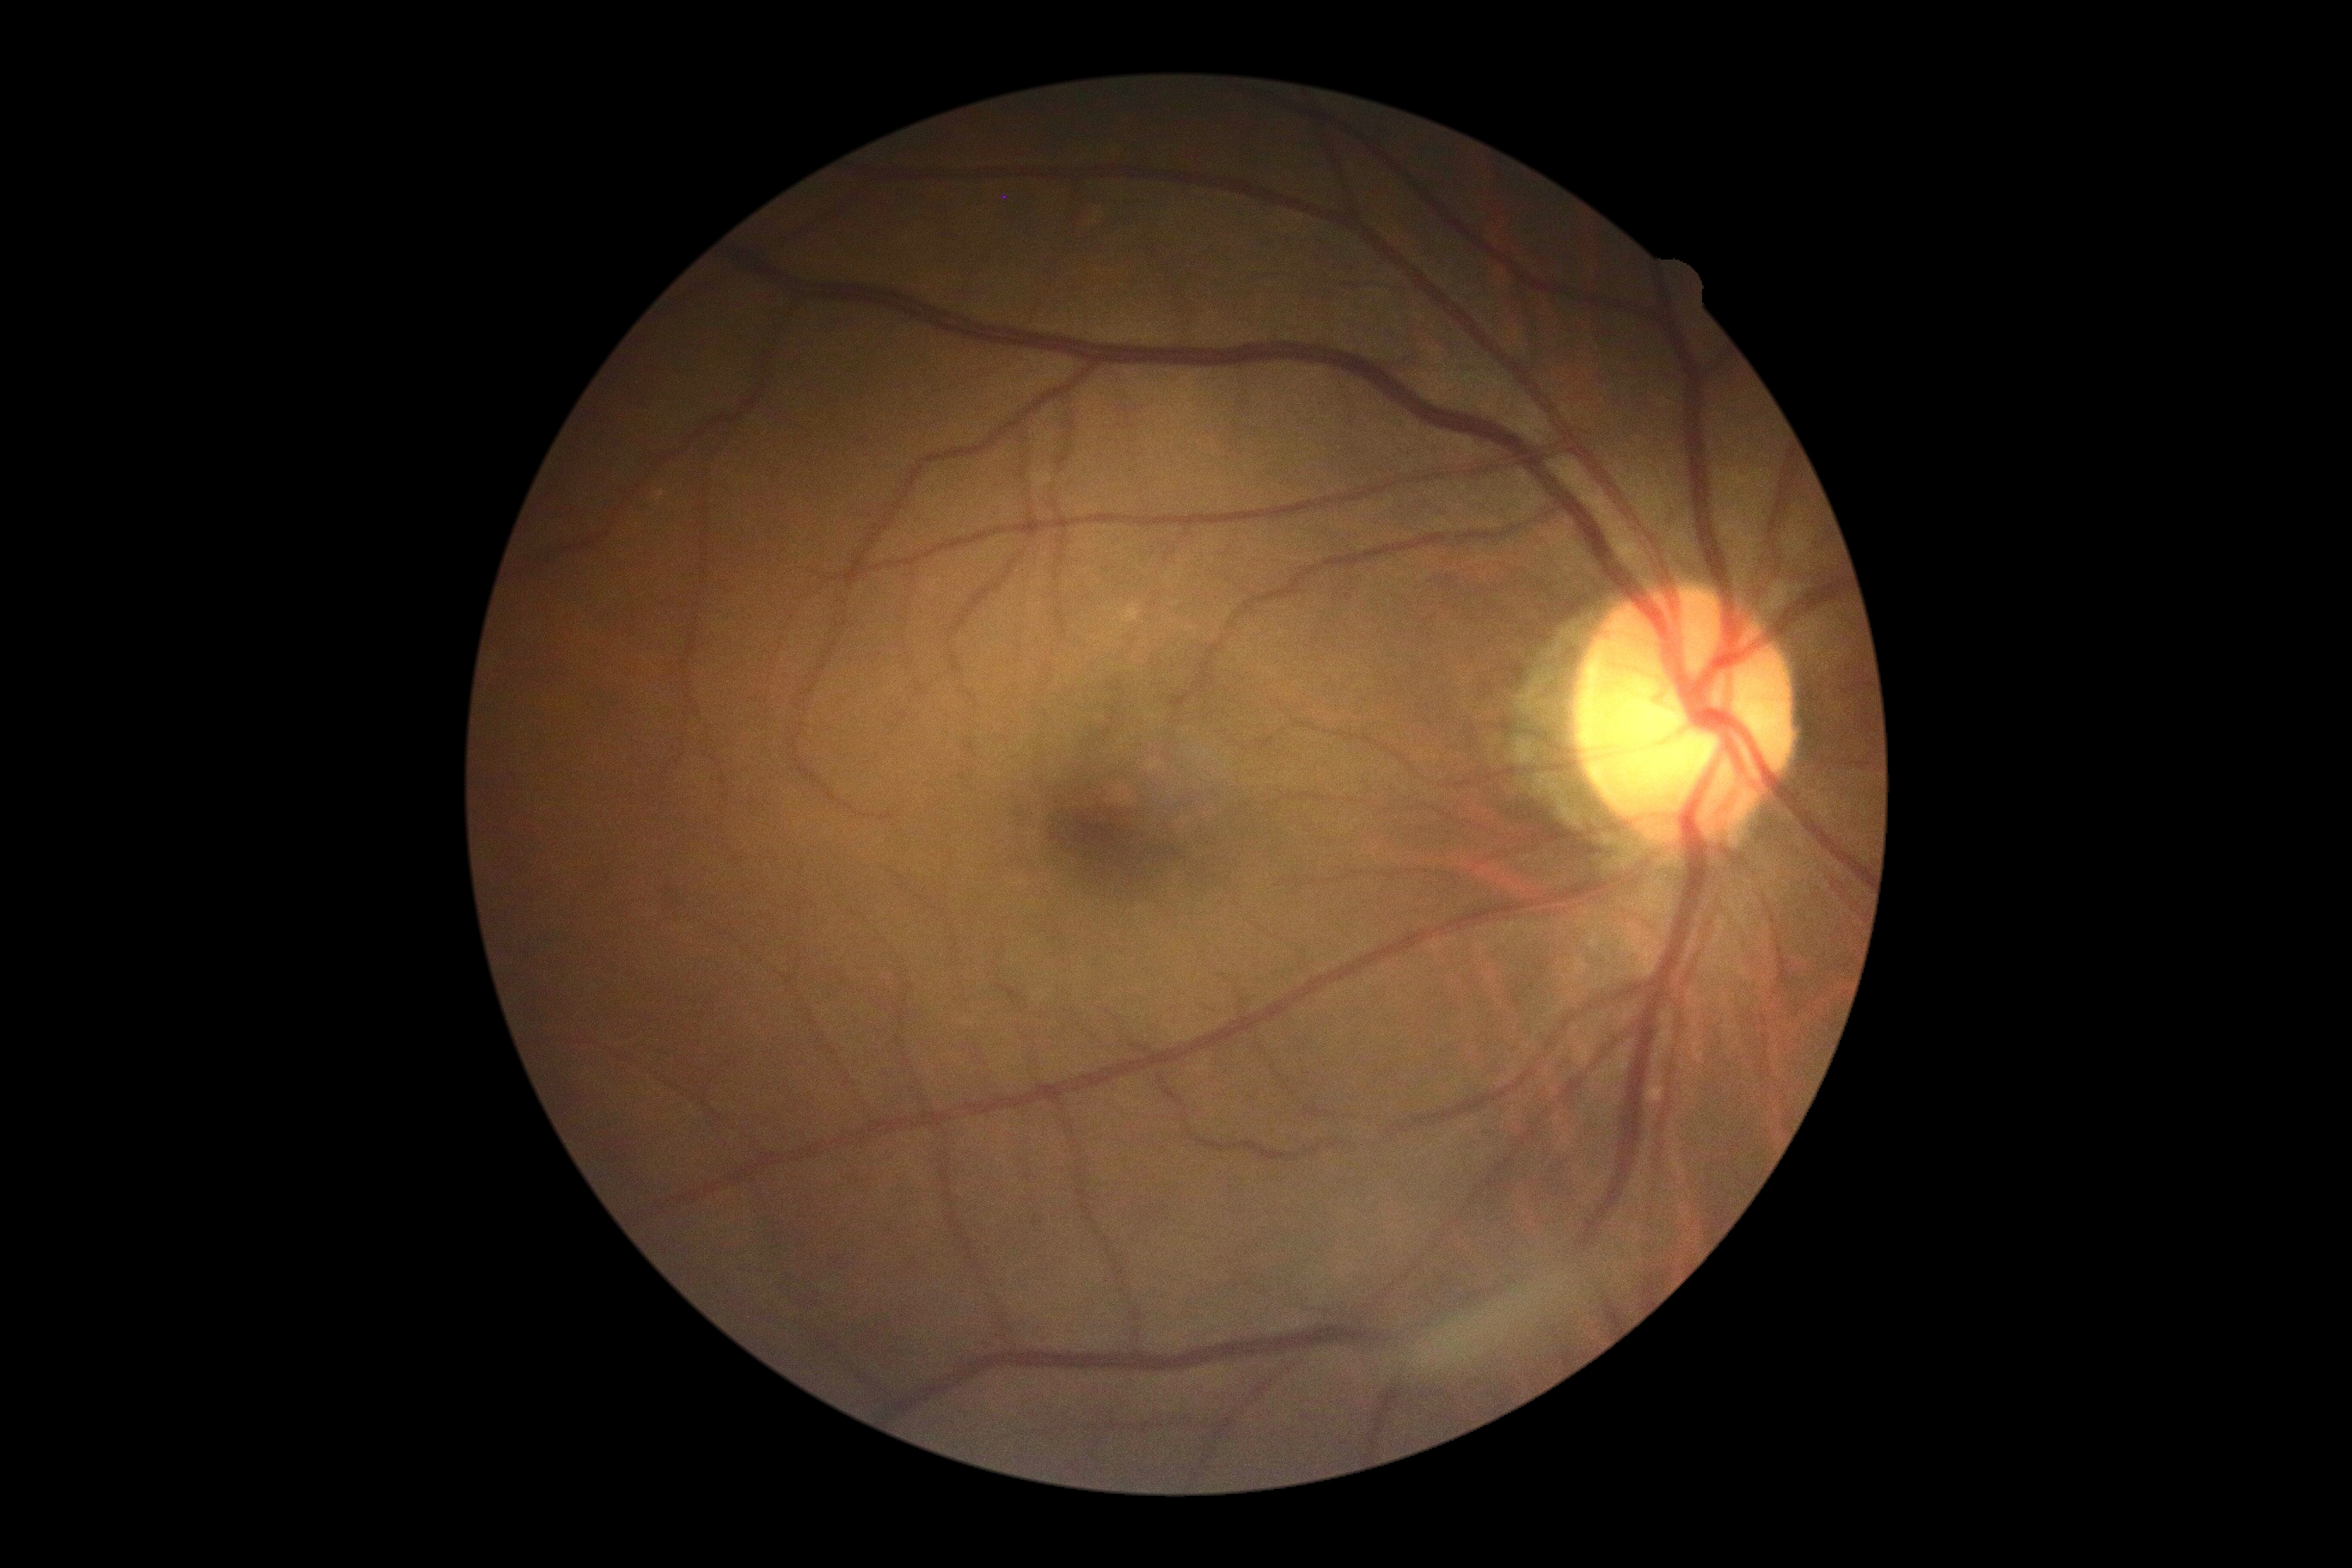

{"dr_grade": "0"}